Infant wide-field fundus photograph · 1240 by 1240 pixels.
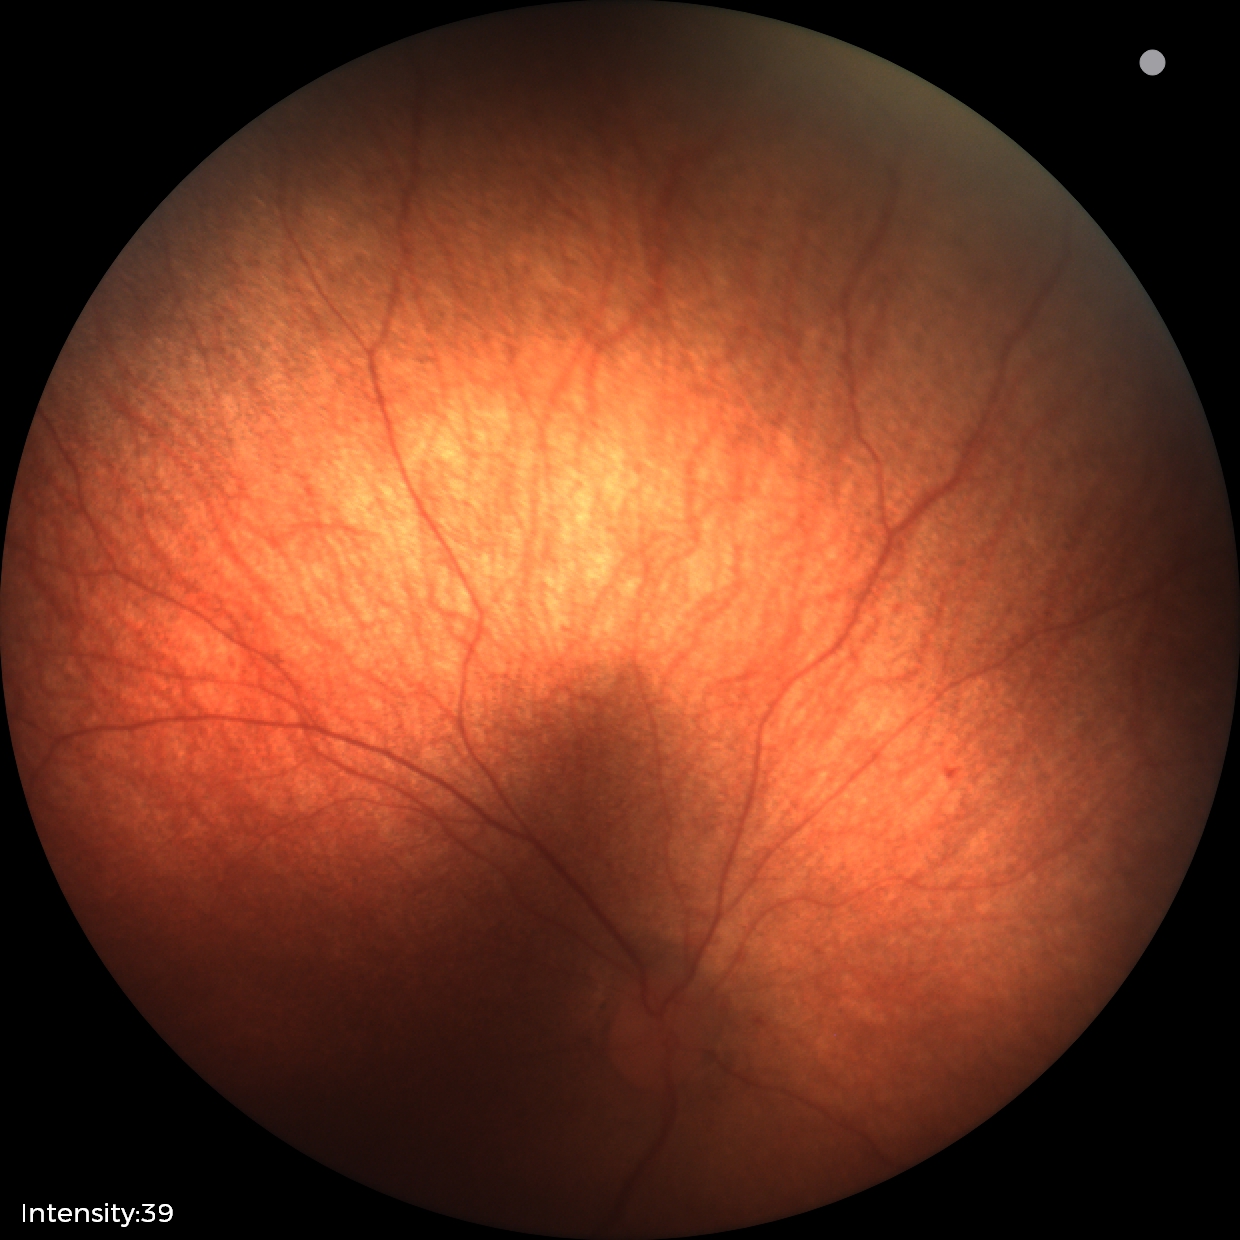

Screening examination with no abnormal retinal findings.